1624 x 1232 pixels
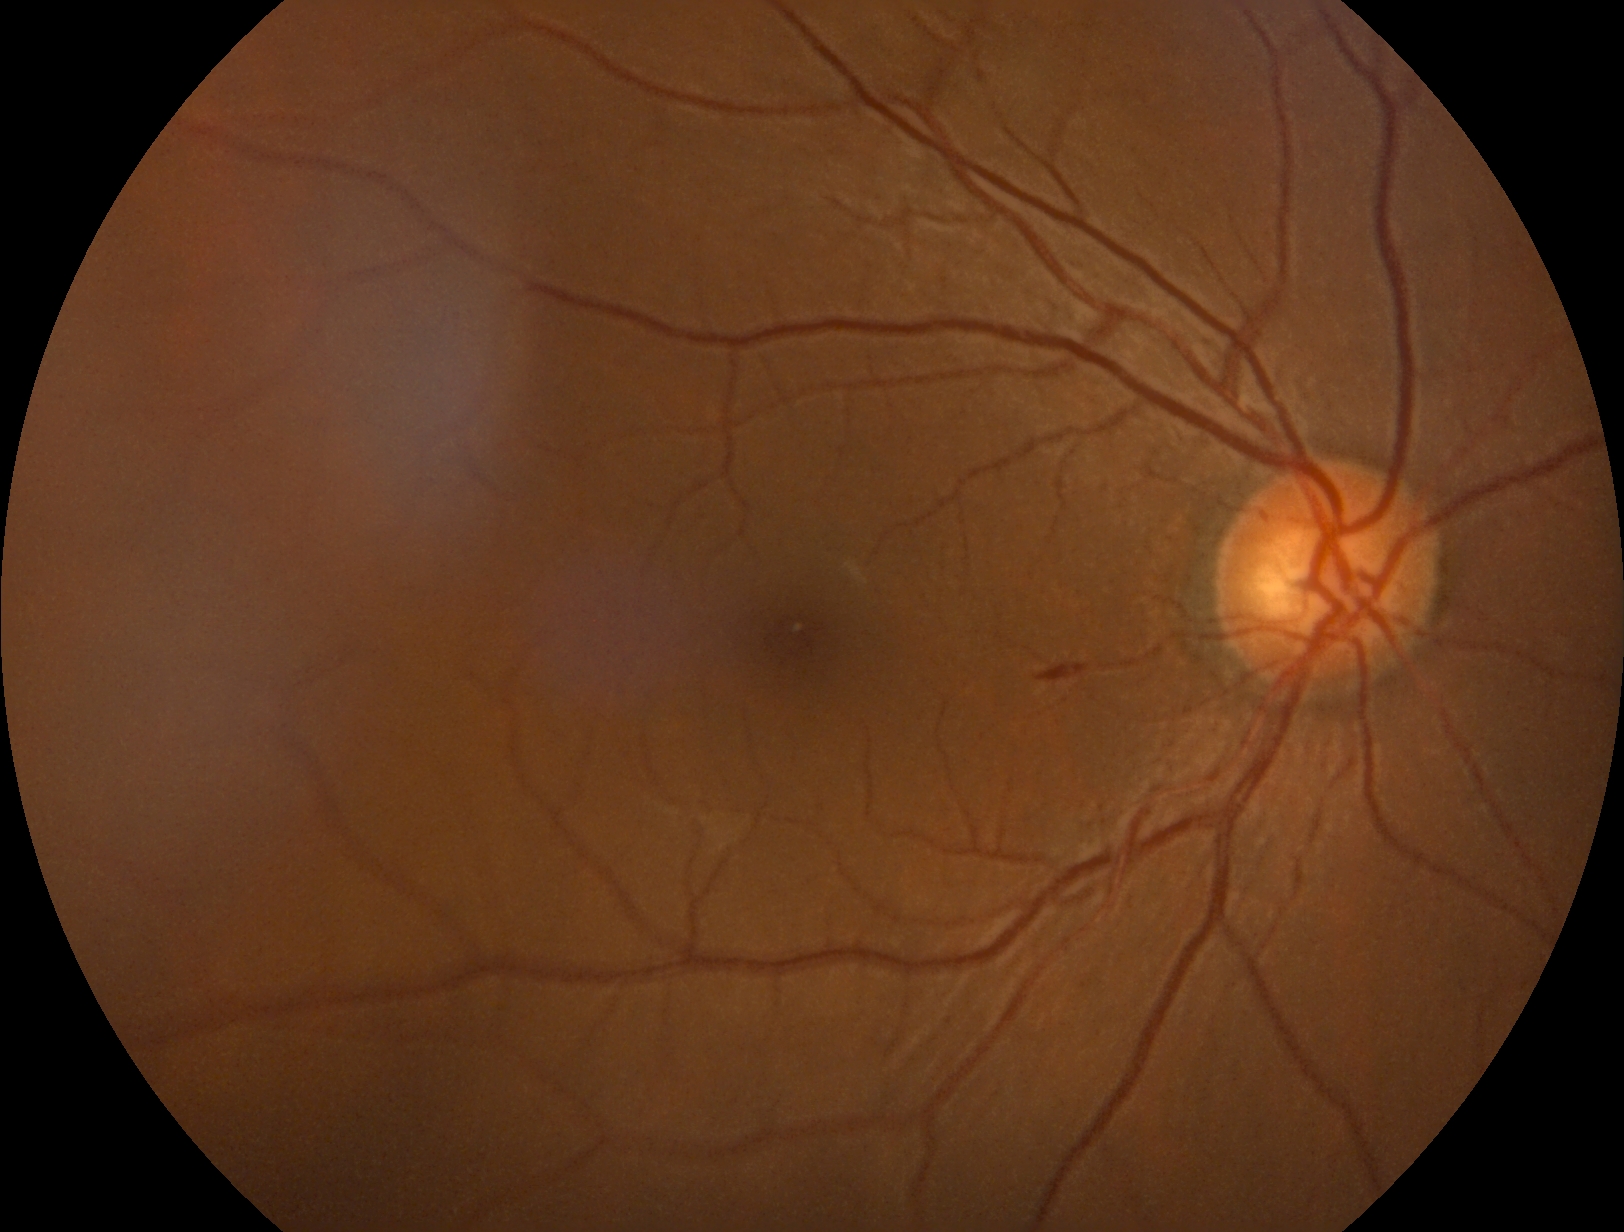

DR severity: 2/4.